FOV: 45 degrees:
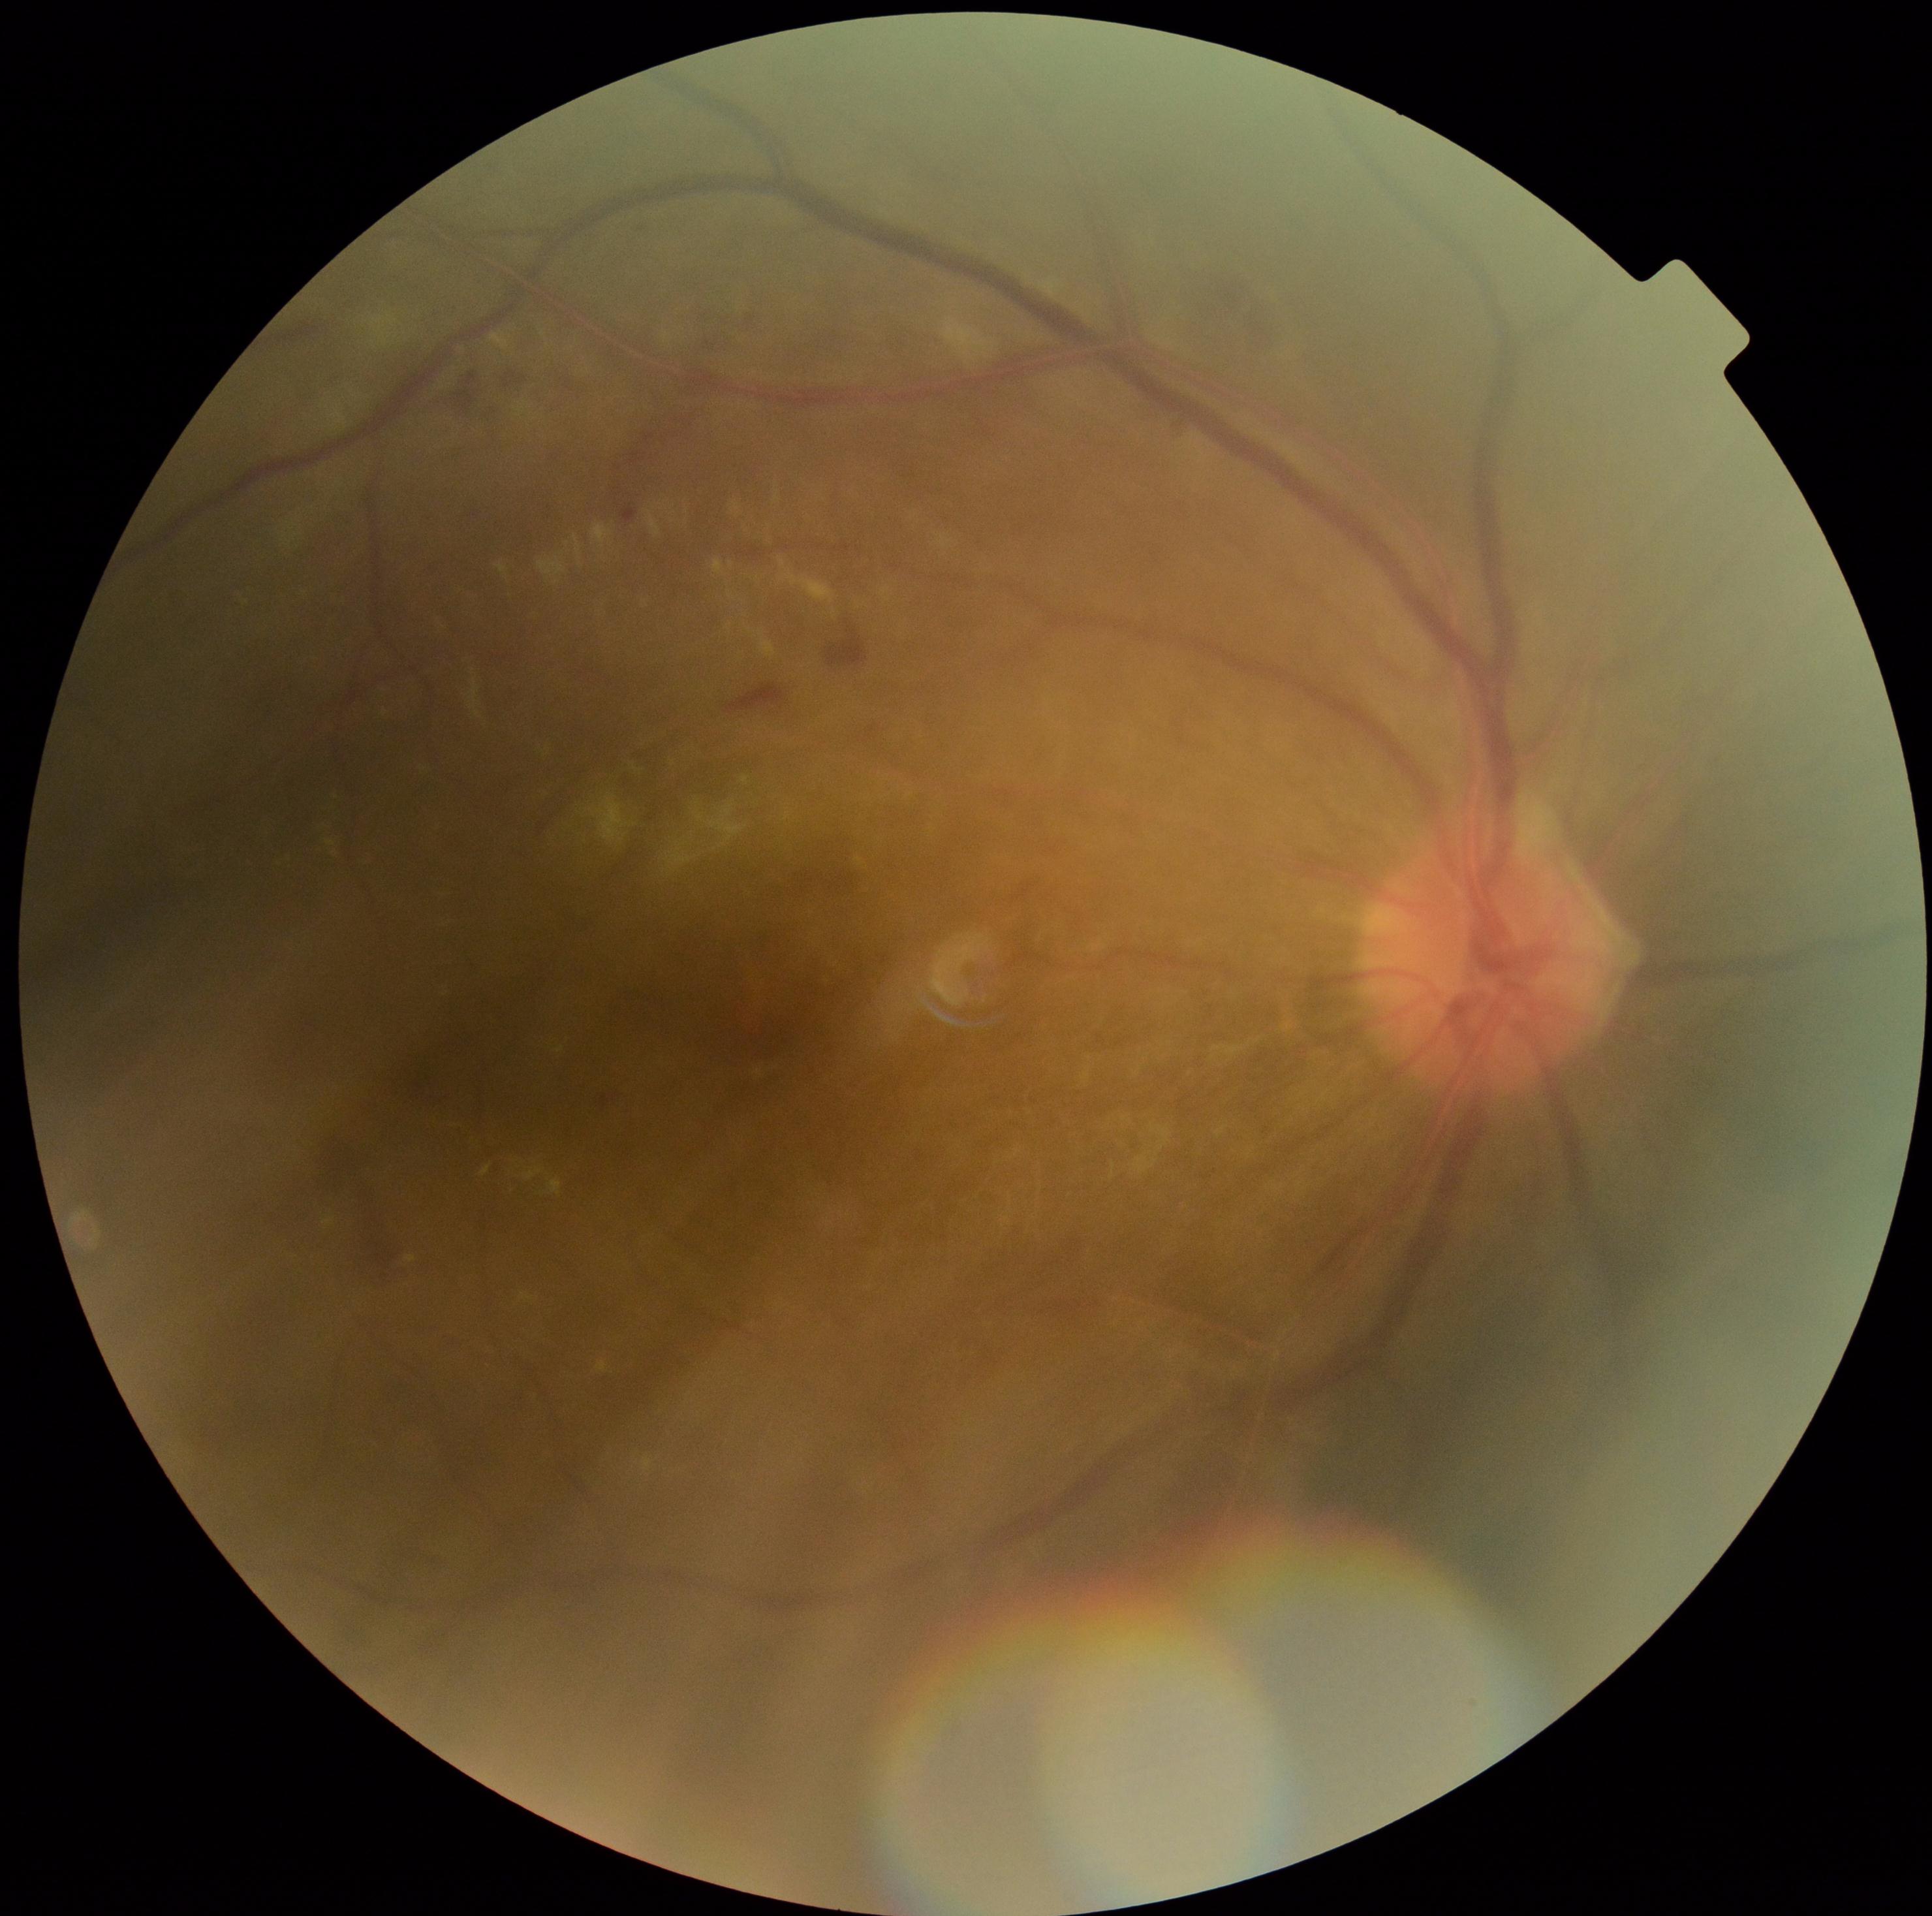
Retinopathy grade: 2.